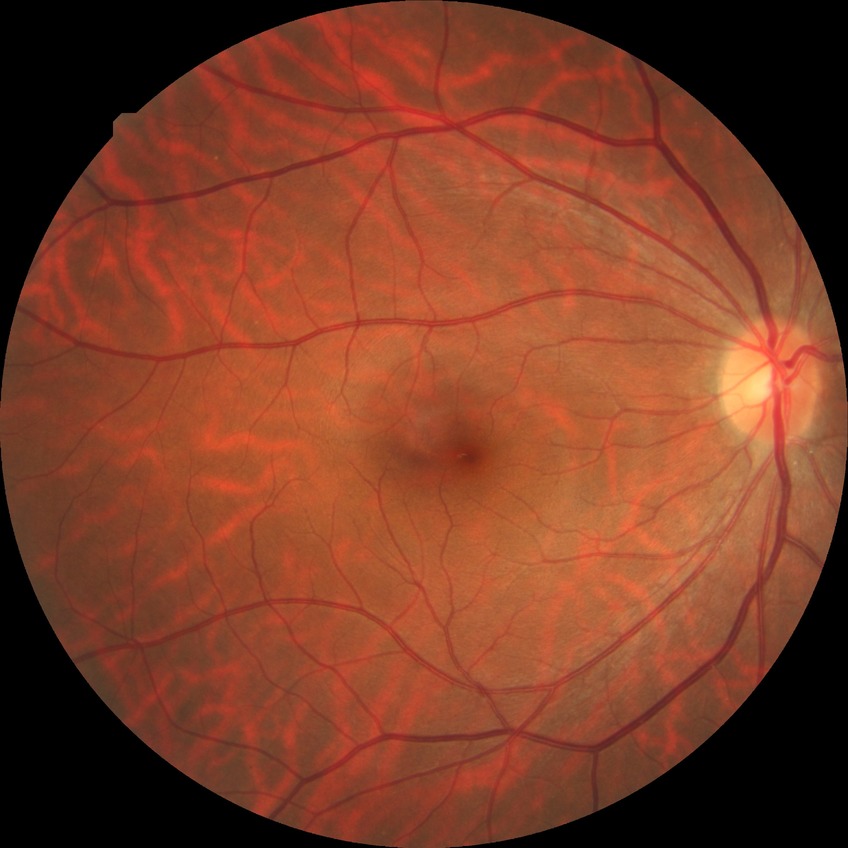 DR severity is NDR.